Color fundus photograph, image size 2048x1536, 45° FOV:
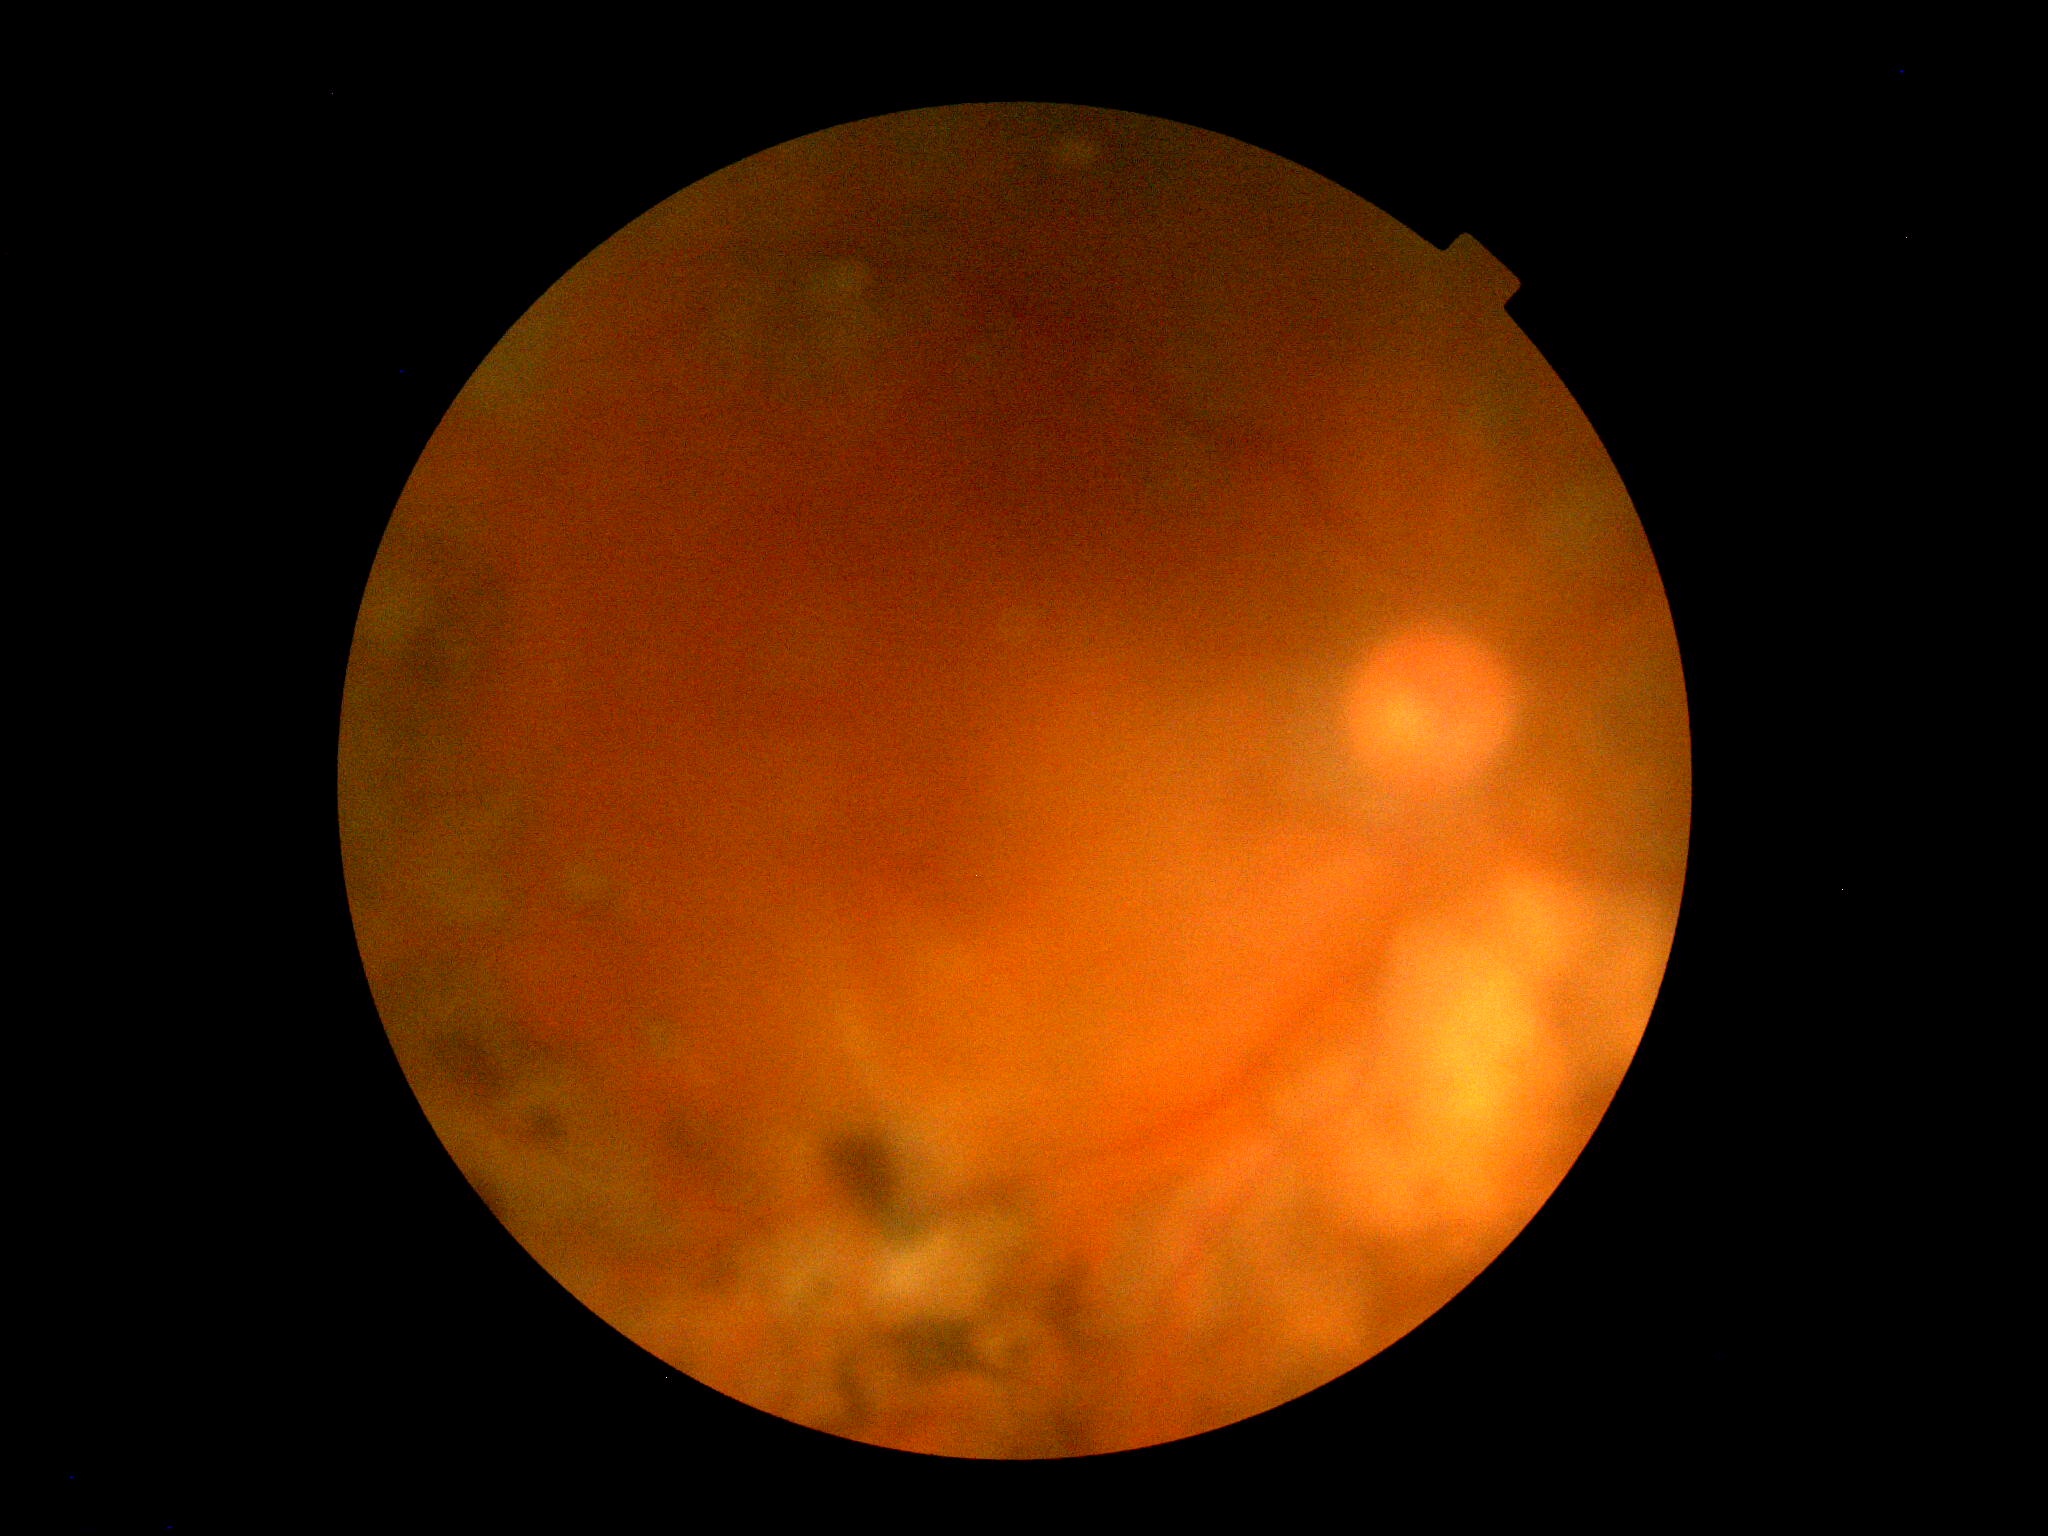
Findings:
- diabetic retinopathy (DR): ungradable
- image quality: too poor for DR grading